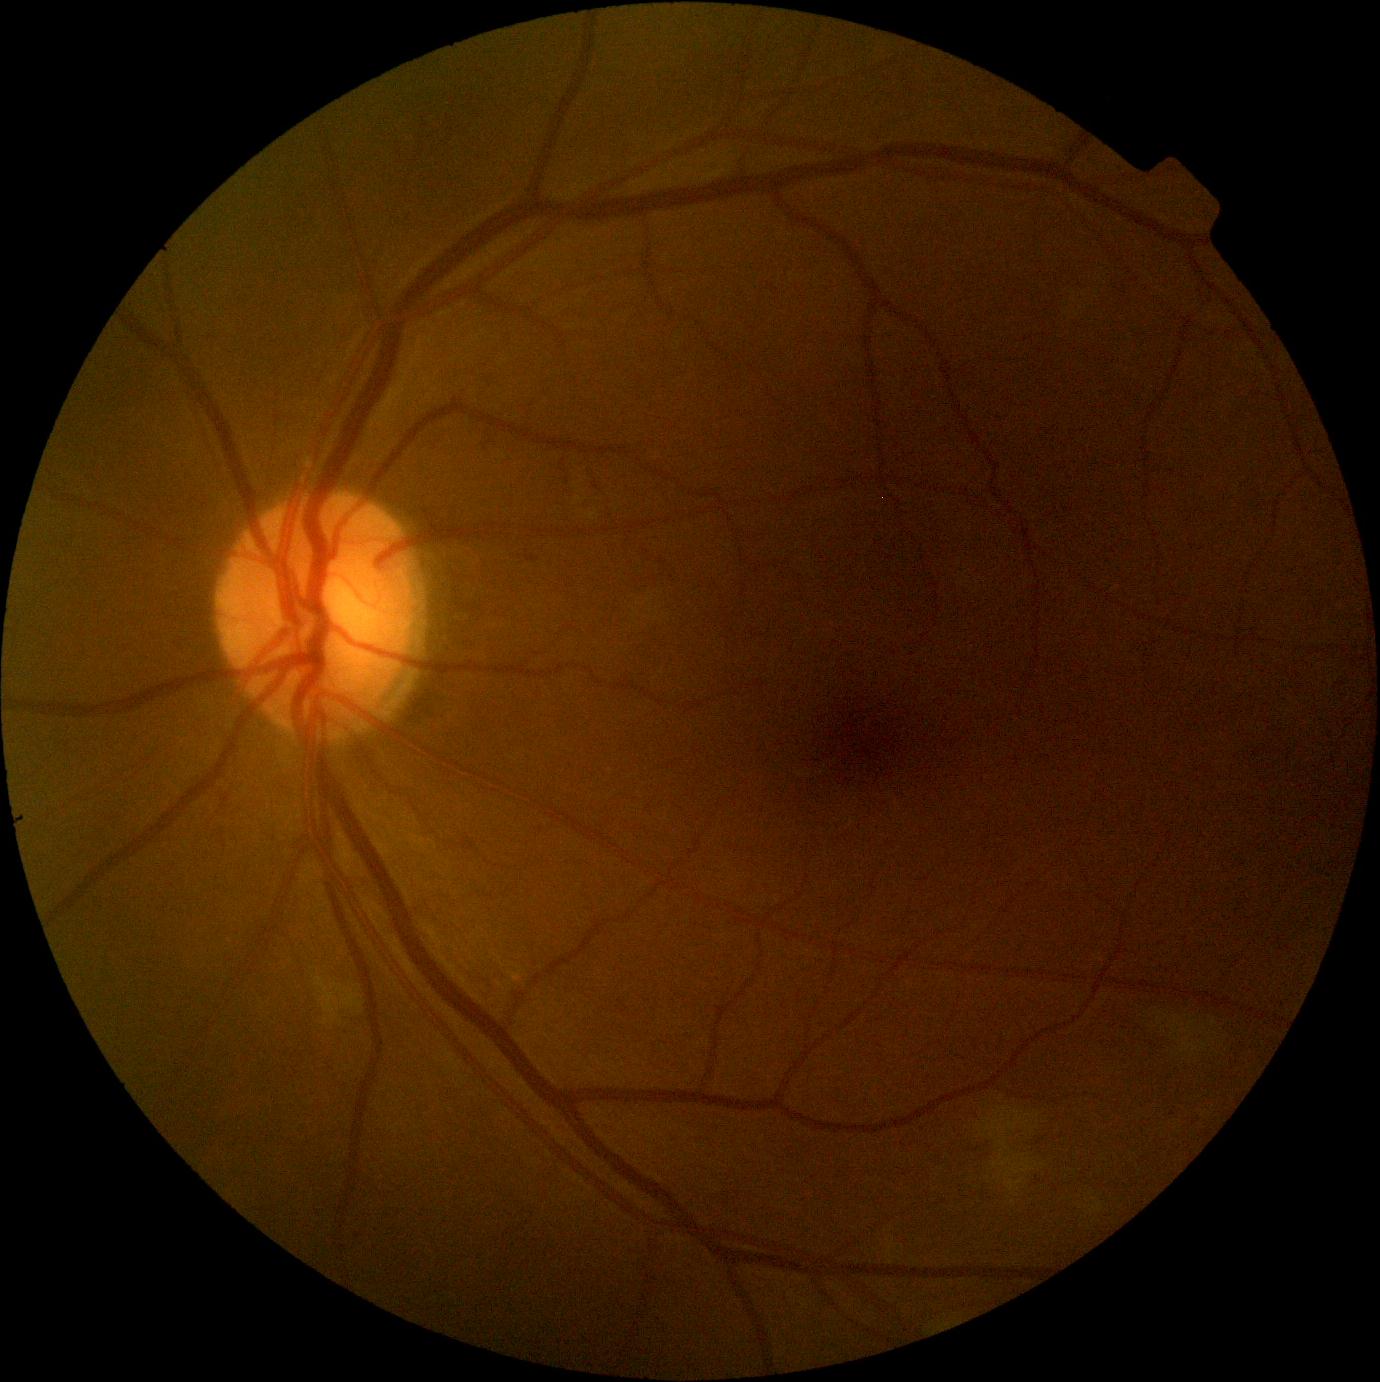 Diabetic retinopathy grade: moderate non-proliferative diabetic retinopathy (2).